FOV: 30 degrees; IOP 22 mmHg (applanation tonometry); age 50
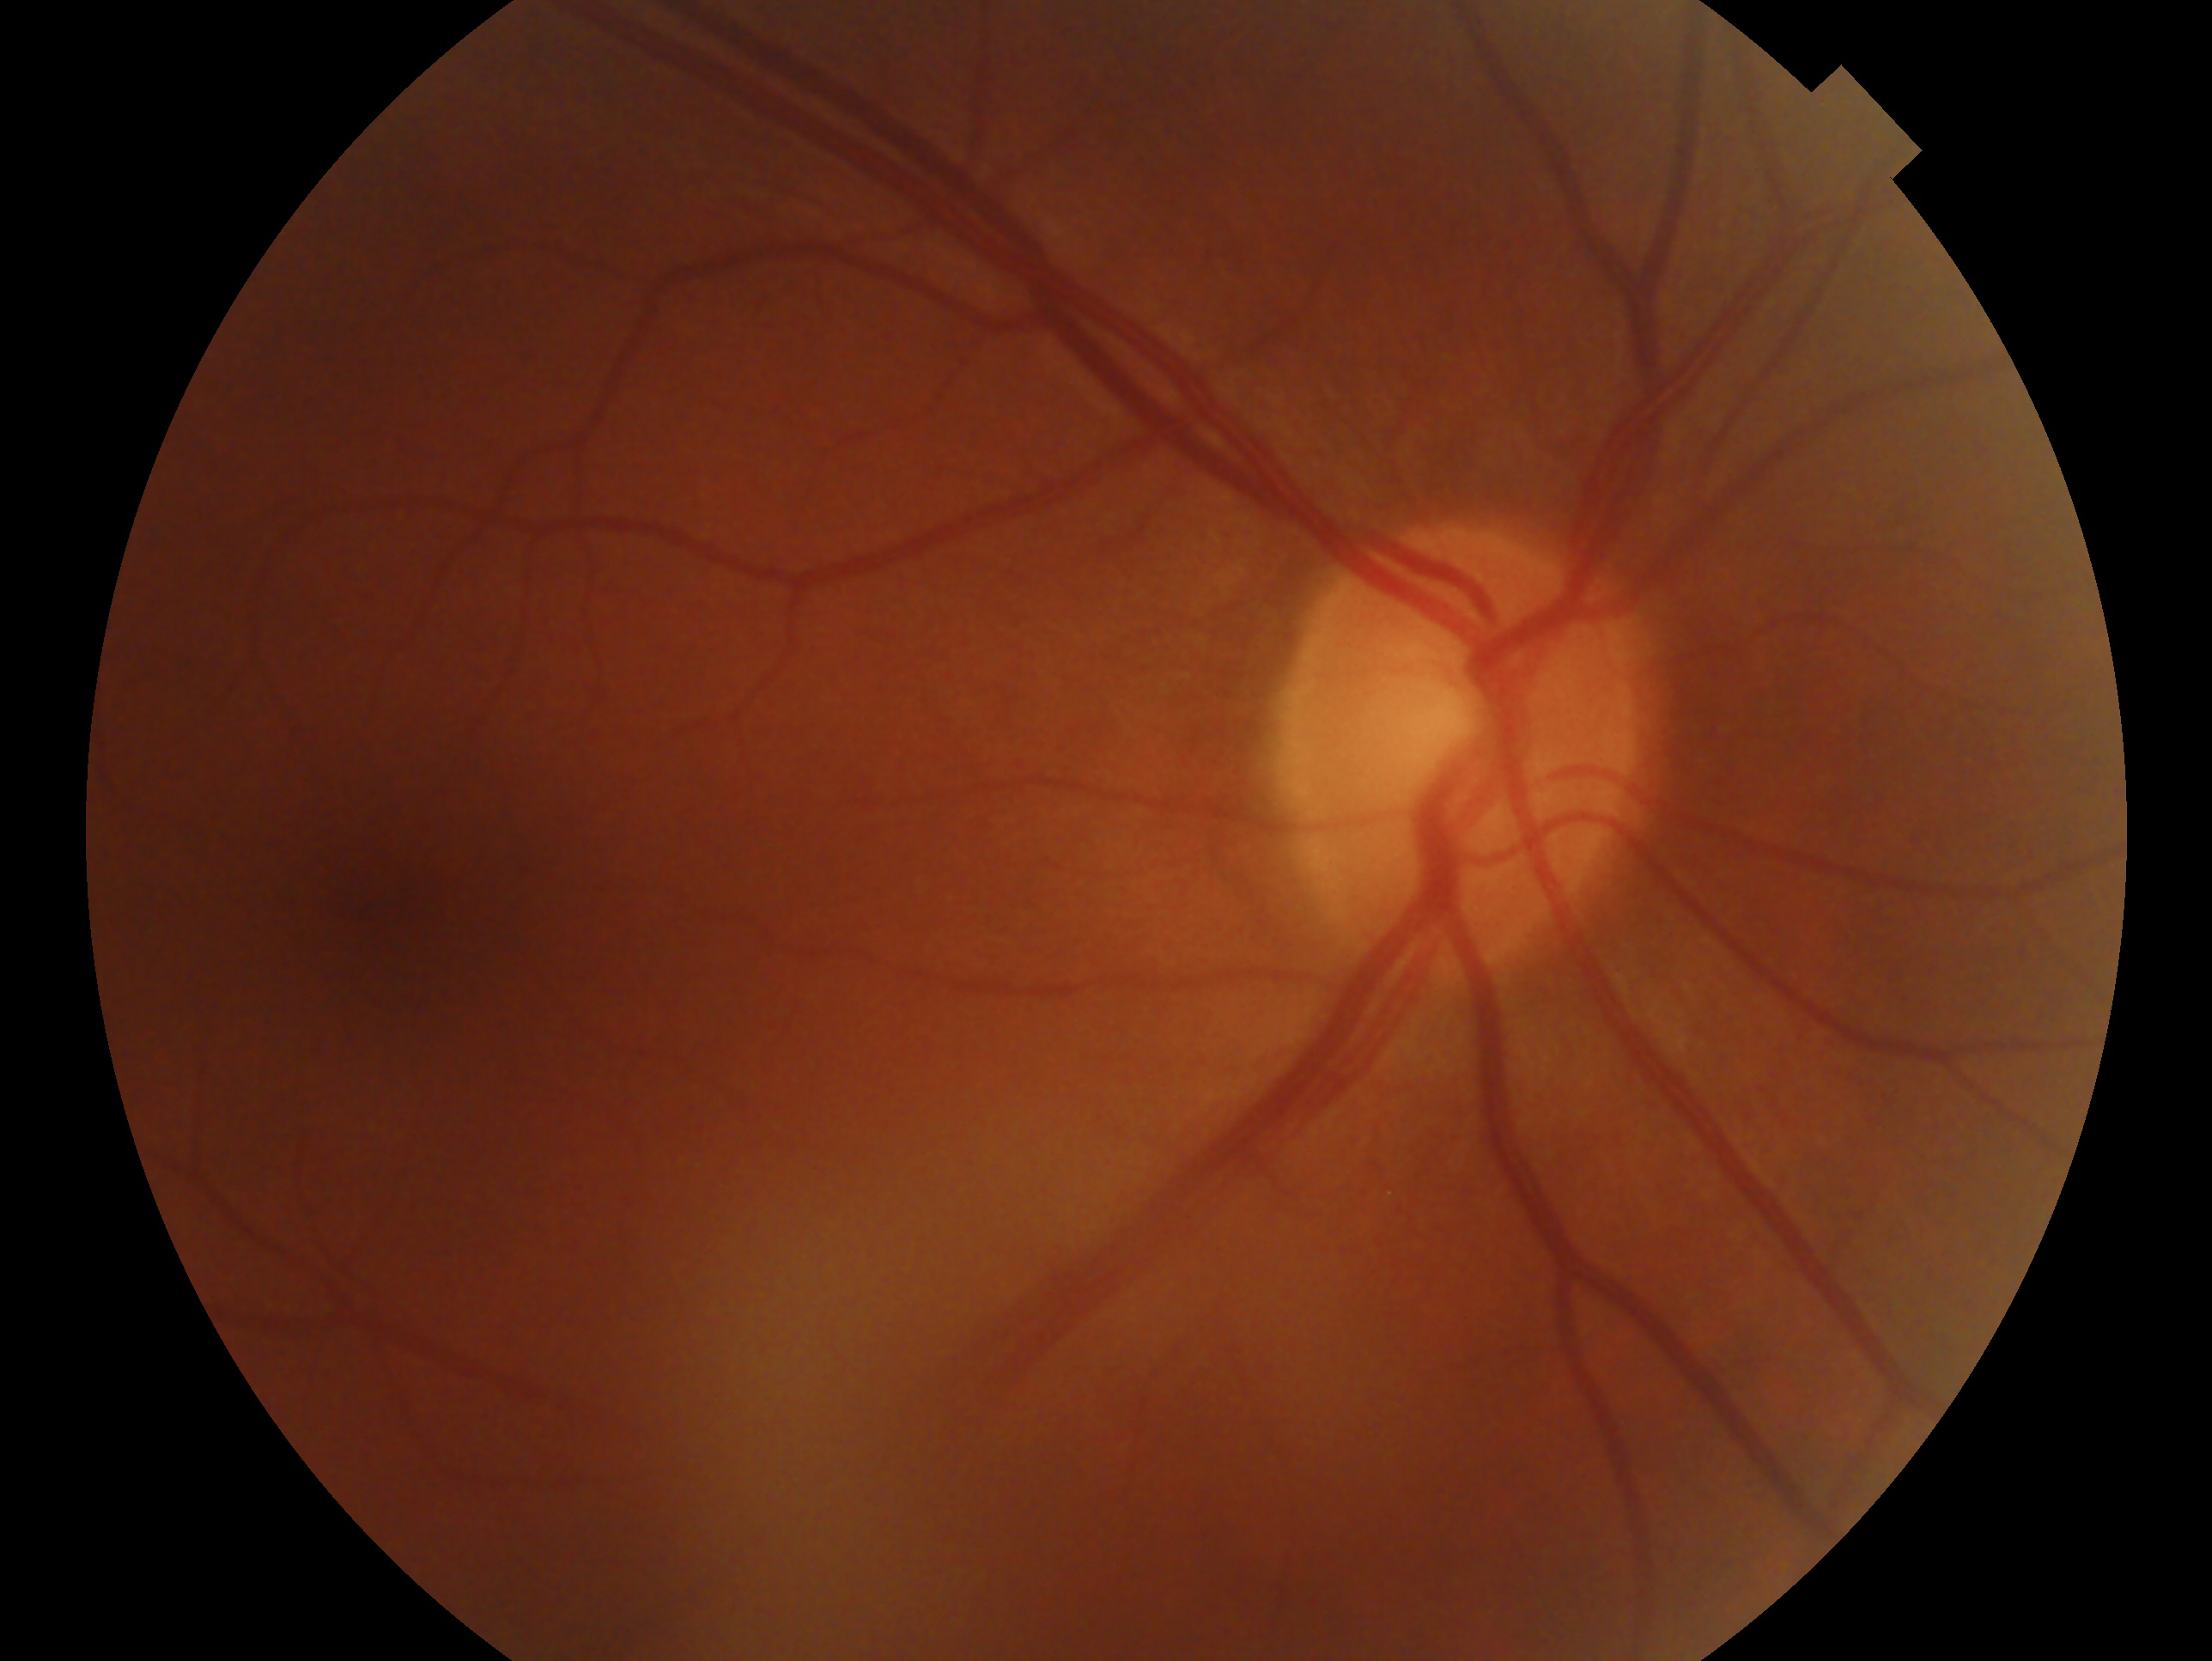

Clinical classification: suspicious for glaucoma.
Imaged eye: oculus dexter.